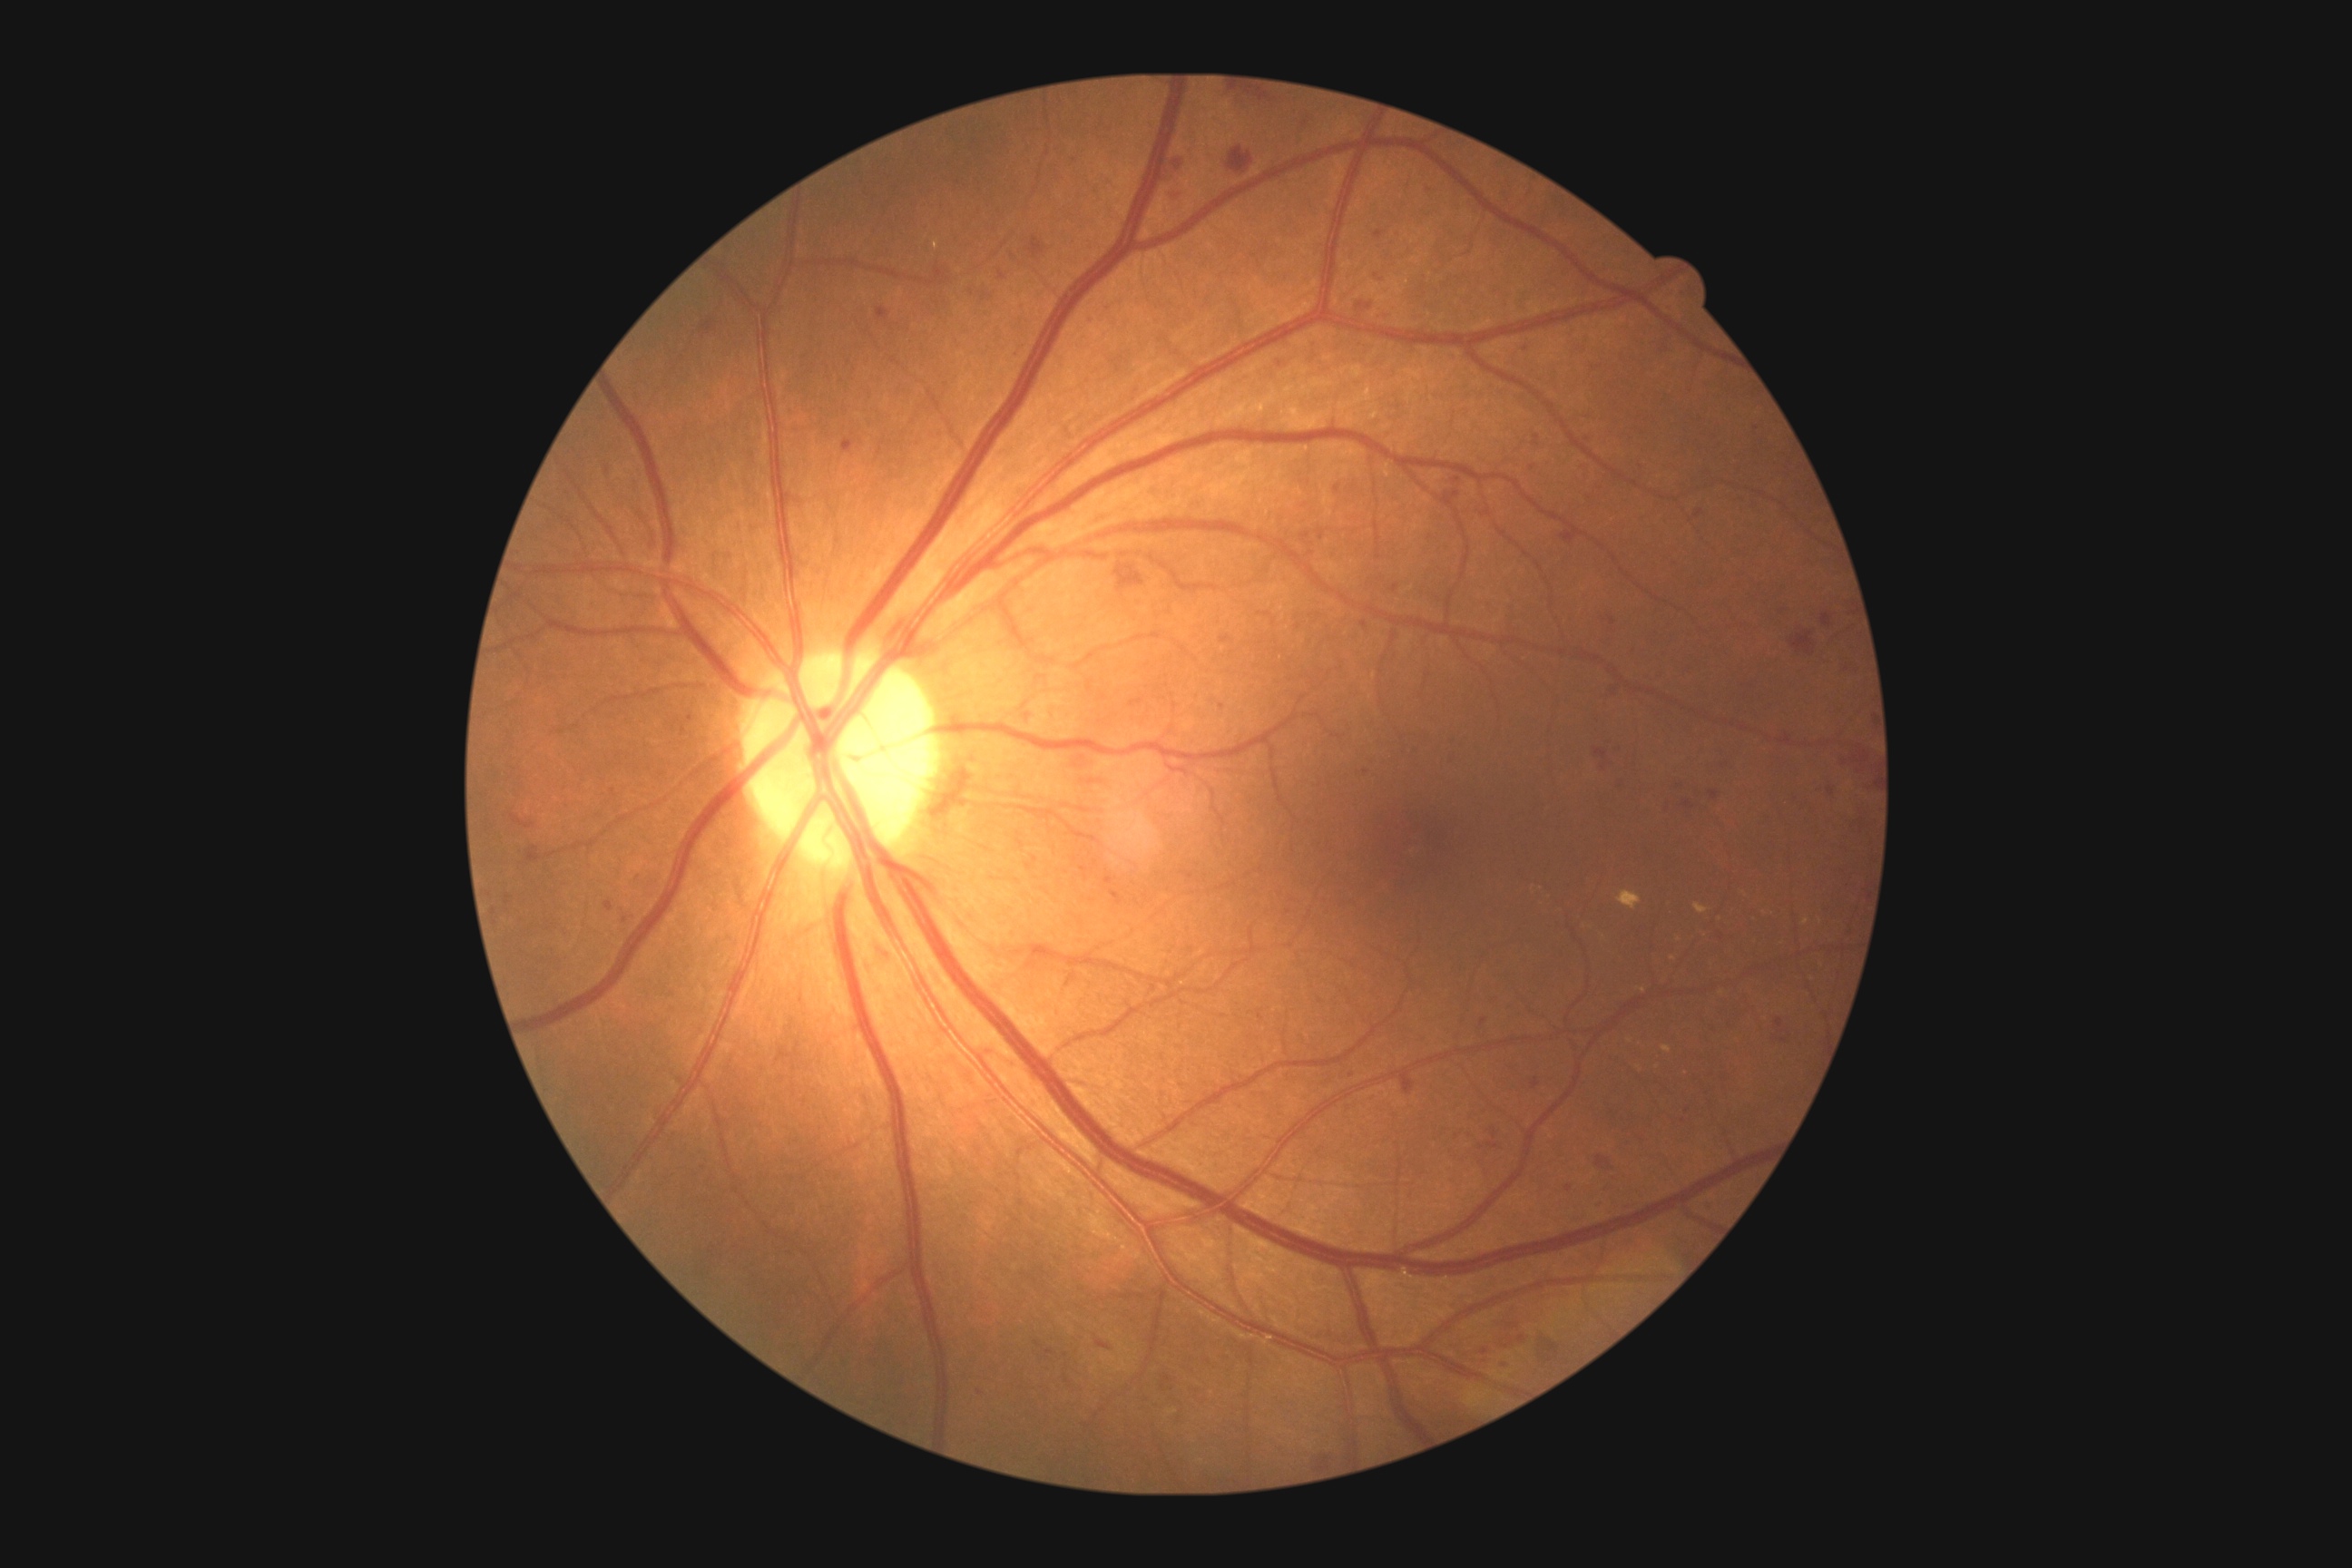
Diabetic retinopathy grade: 2. Hemorrhages include those at 983 291 992 300 | 1398 1070 1415 1093 | 1357 302 1373 309 | 527 847 542 863 | 1703 1200 1716 1213 | 1063 752 1099 770 | 1661 798 1671 814 | 1838 660 1863 680 | 1534 1328 1563 1364 | 701 320 716 335 | 1685 801 1694 808 | 493 908 498 916 | 1609 616 1616 627 | 1026 863 1032 872 | 1130 700 1144 707. Small hemorrhages near x=1485, y=1352 | x=1722, y=938 | x=1351, y=1075 | x=1066, y=1379.